848x848px. No pharmacologic dilation.
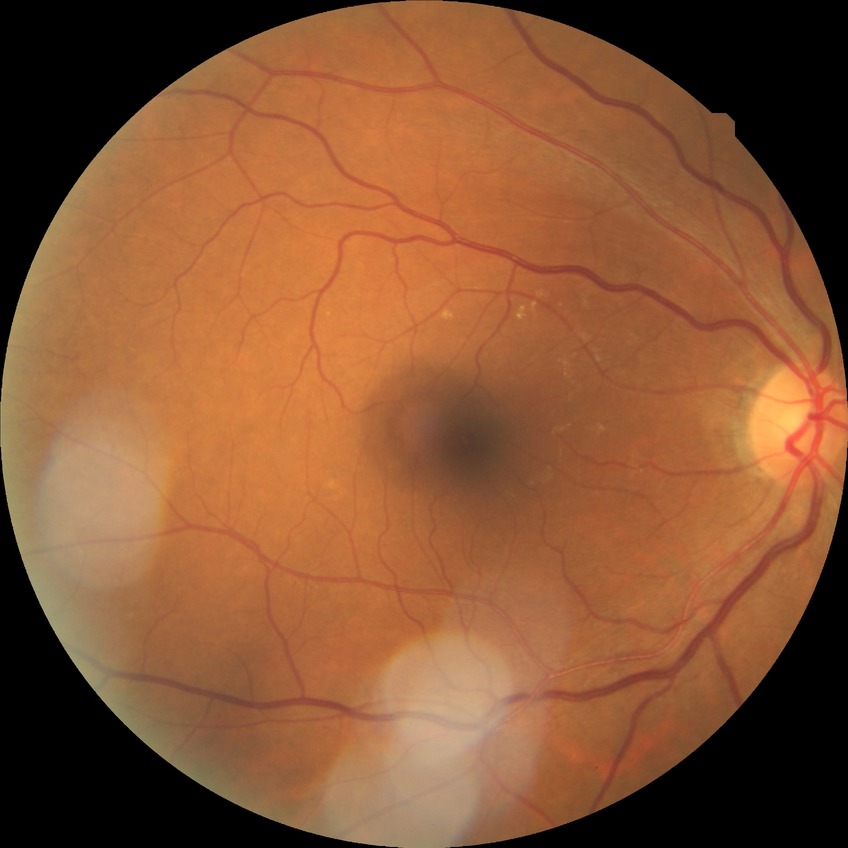
modified Davis classification: no diabetic retinopathy